1380 by 1382 pixels:
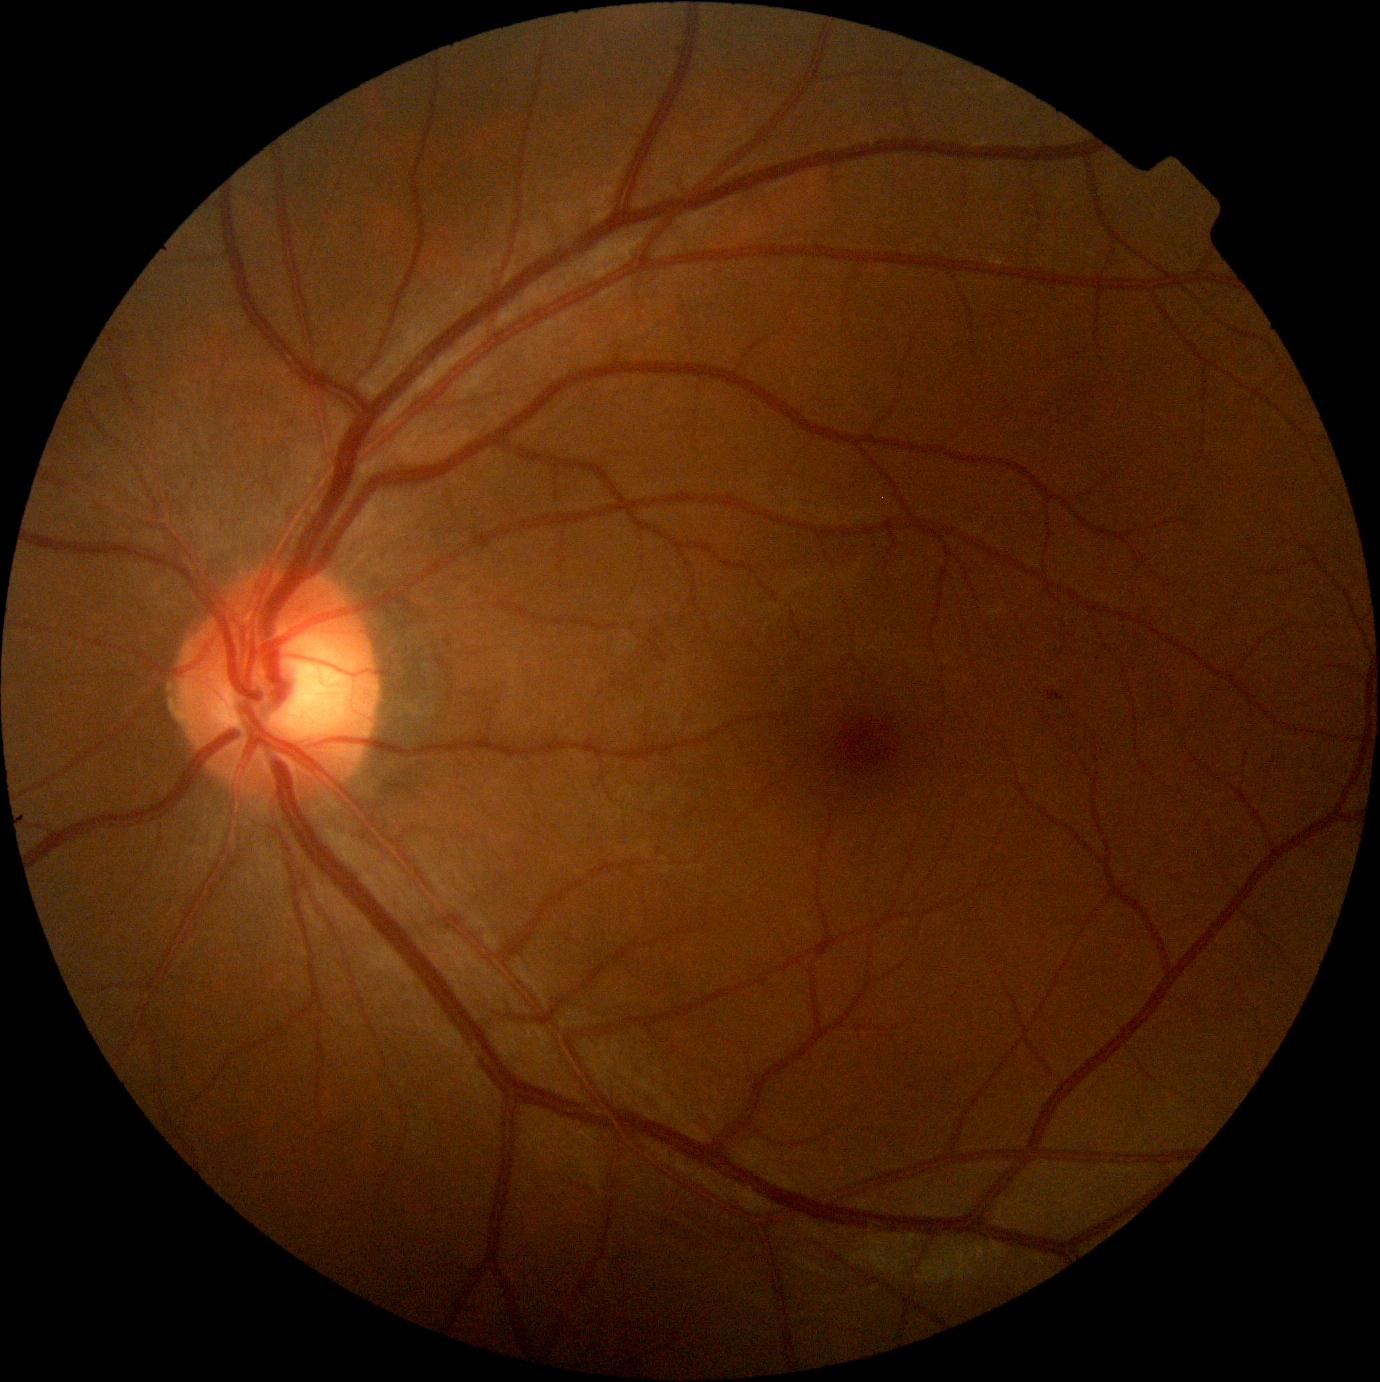
DR class: non-proliferative diabetic retinopathy; retinopathy grade: 1.